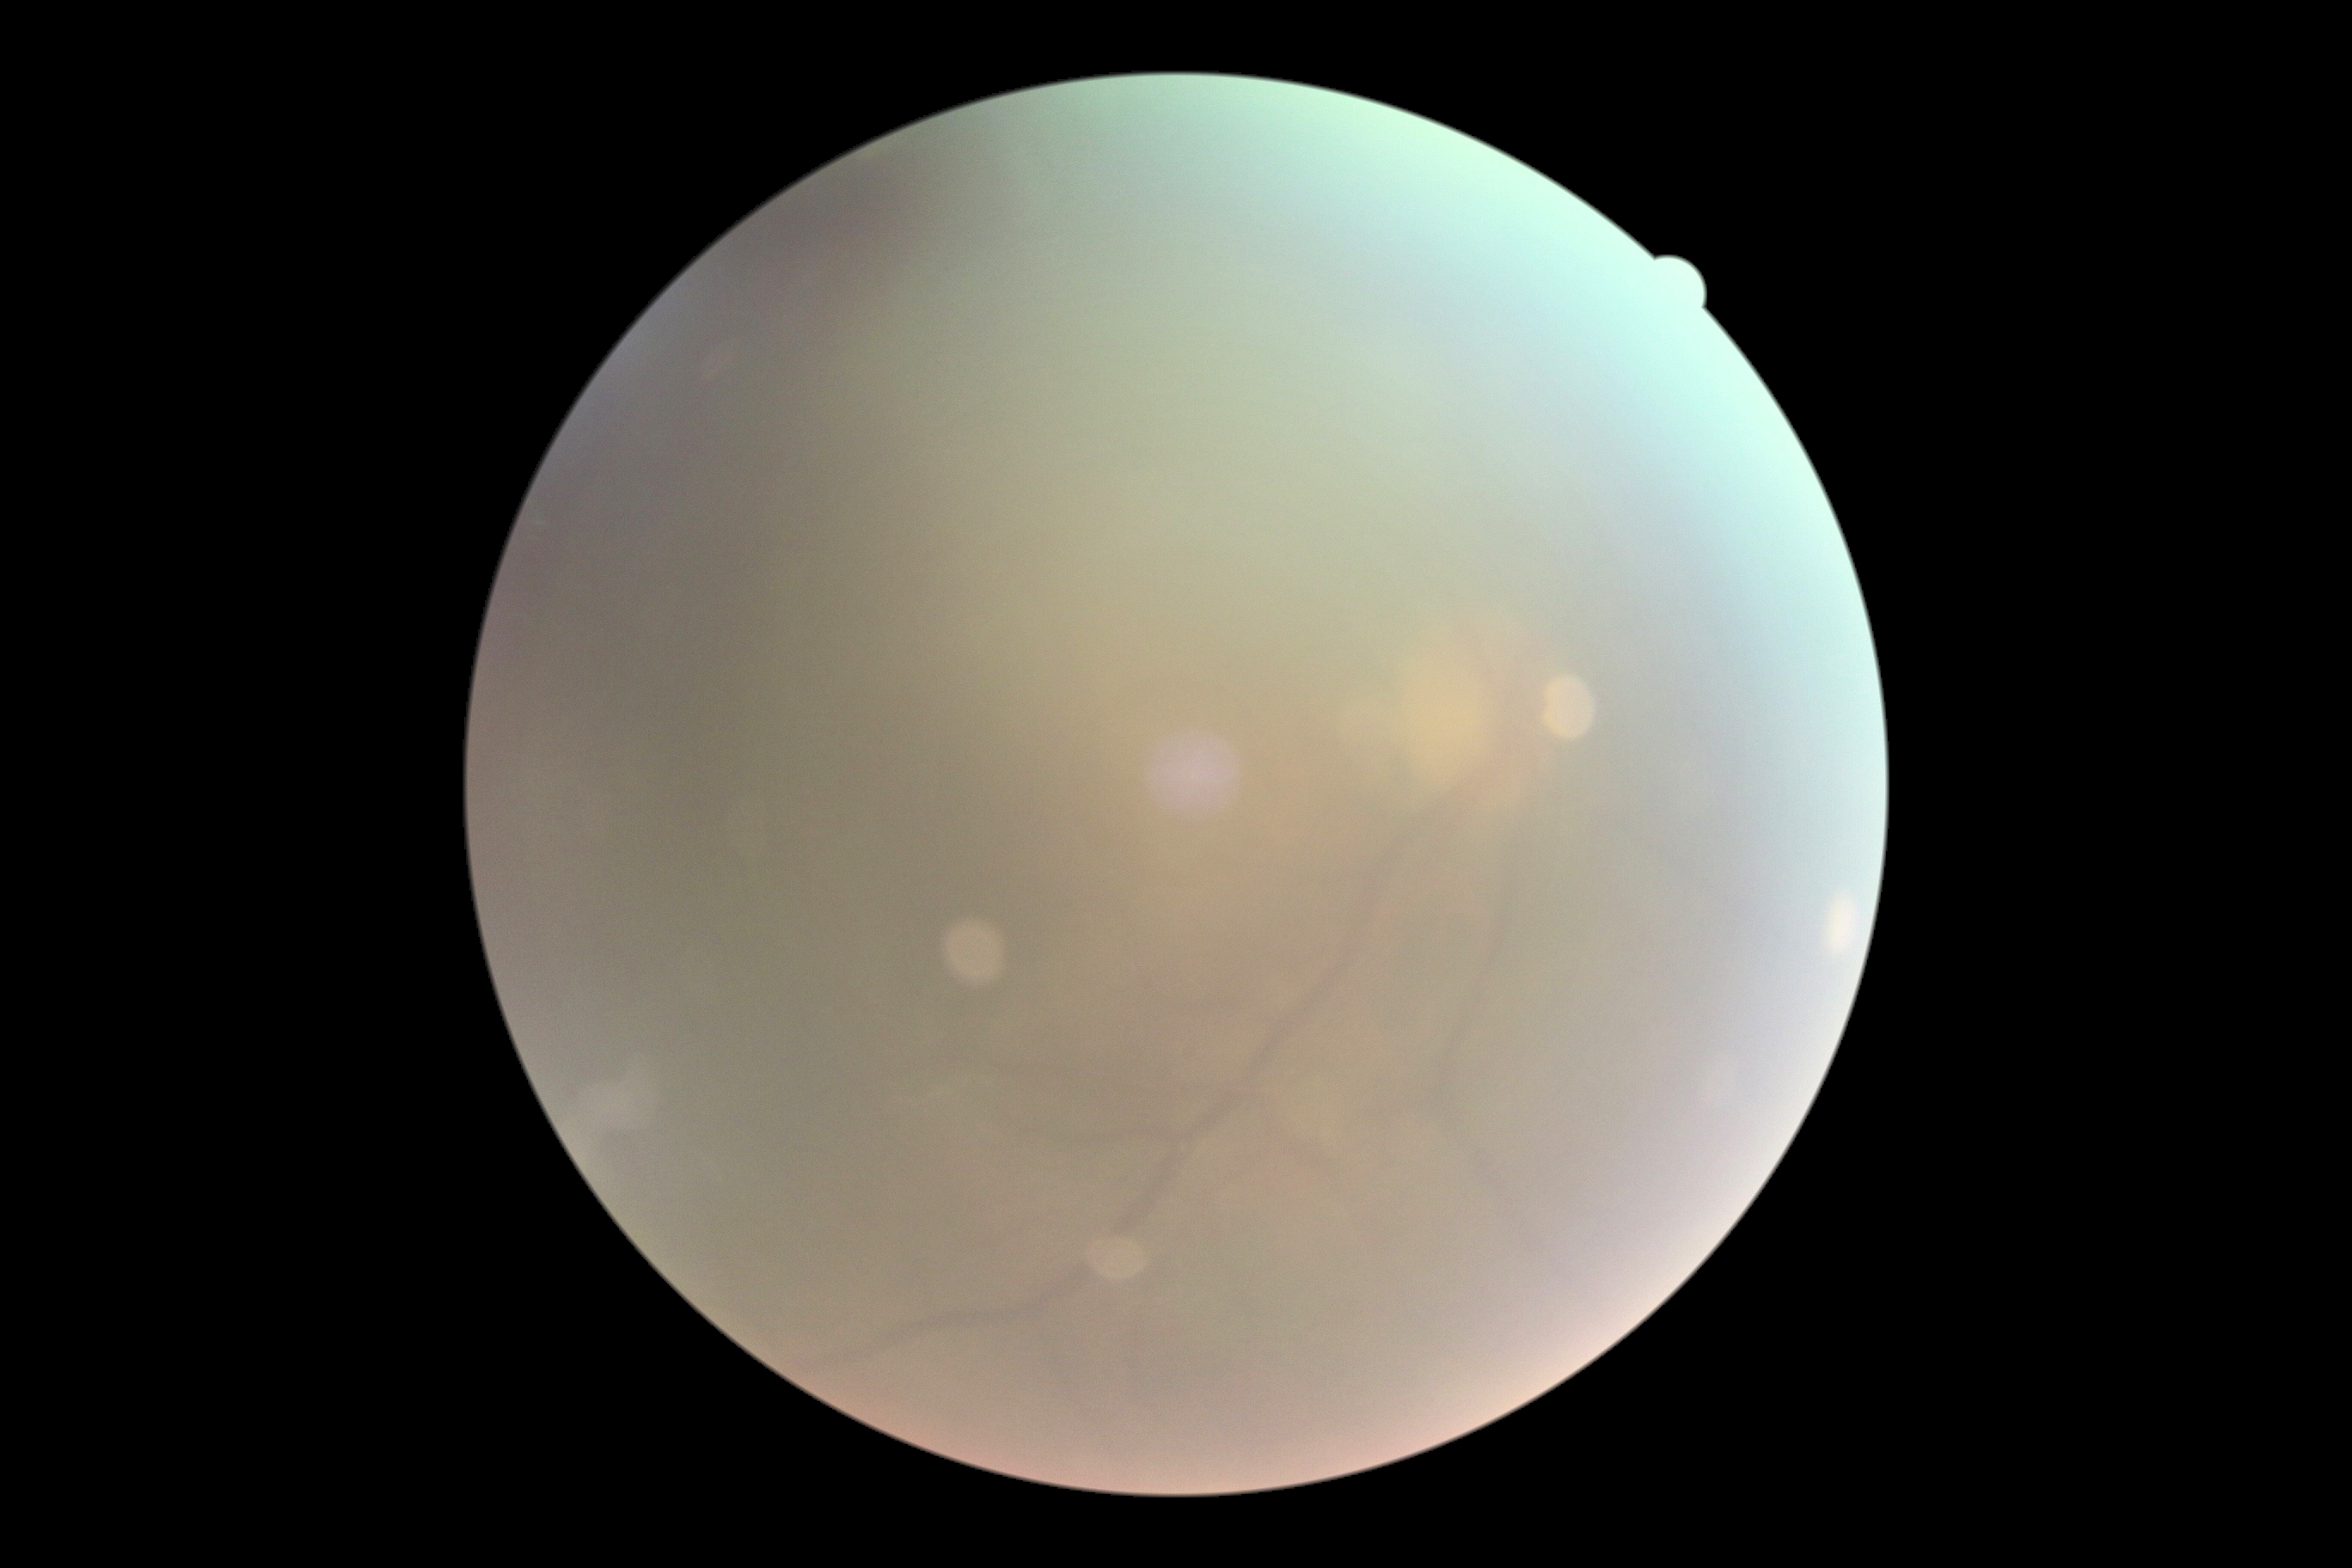
diabetic retinopathy@ungradable due to poor image quality.